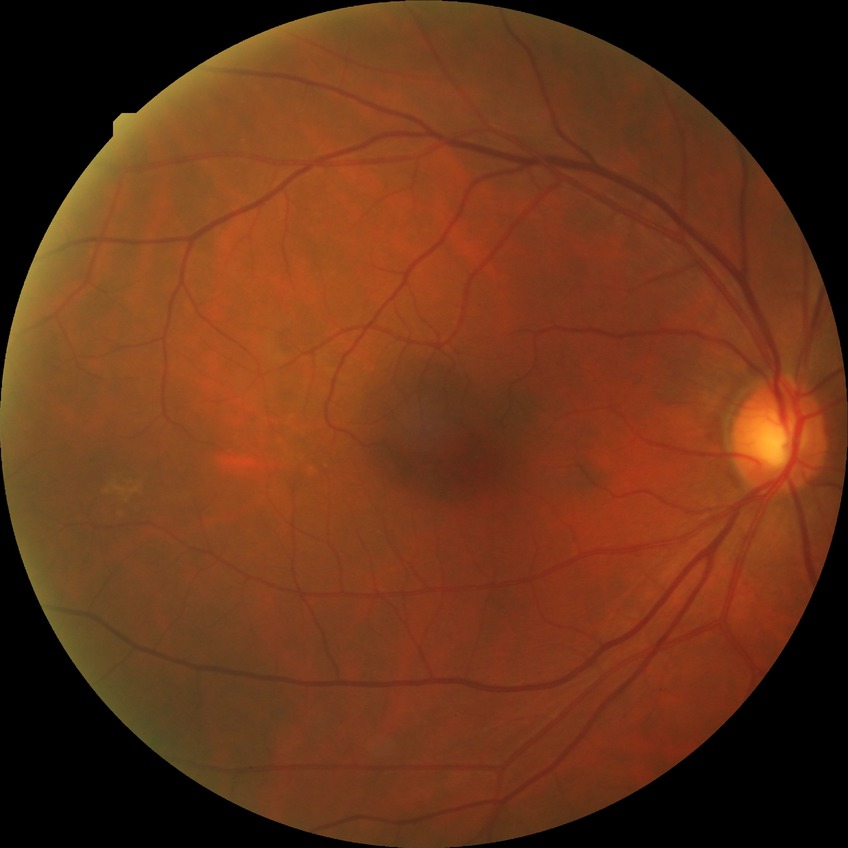 Diabetic retinopathy (DR) is NDR (no diabetic retinopathy).